Infant wide-field fundus photograph; 1440 x 1080 pixels; Natus RetCam Envision, 130° FOV:
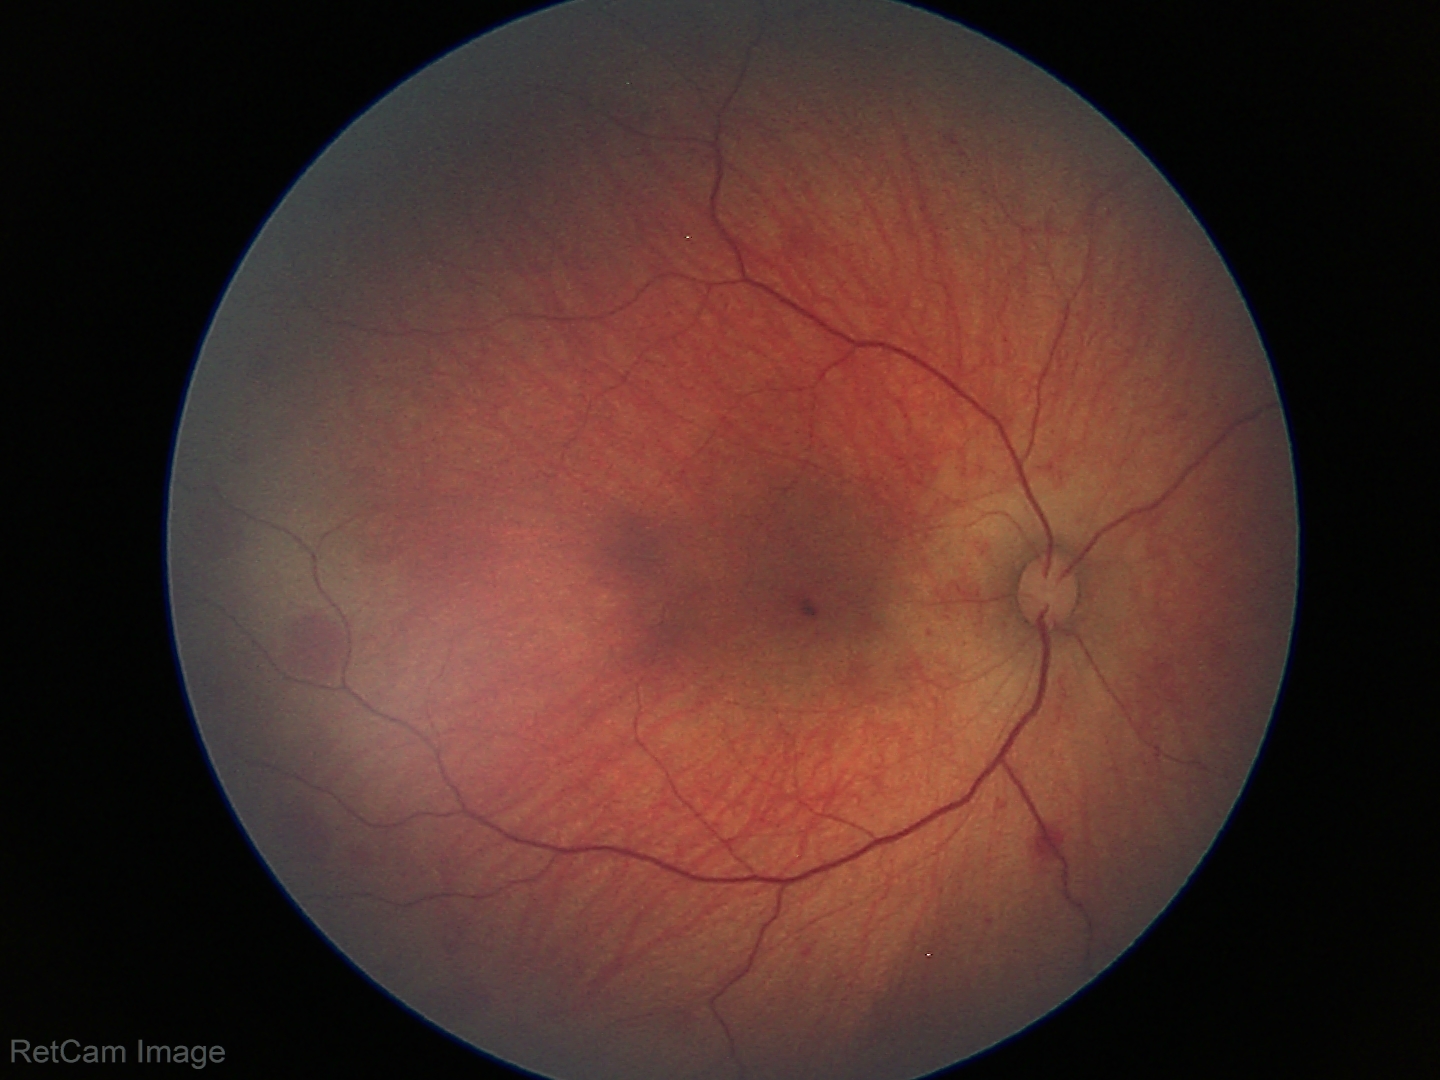

Screening series with retinal hemorrhages.